Posterior pole photograph · without pupil dilation · FOV: 45 degrees.
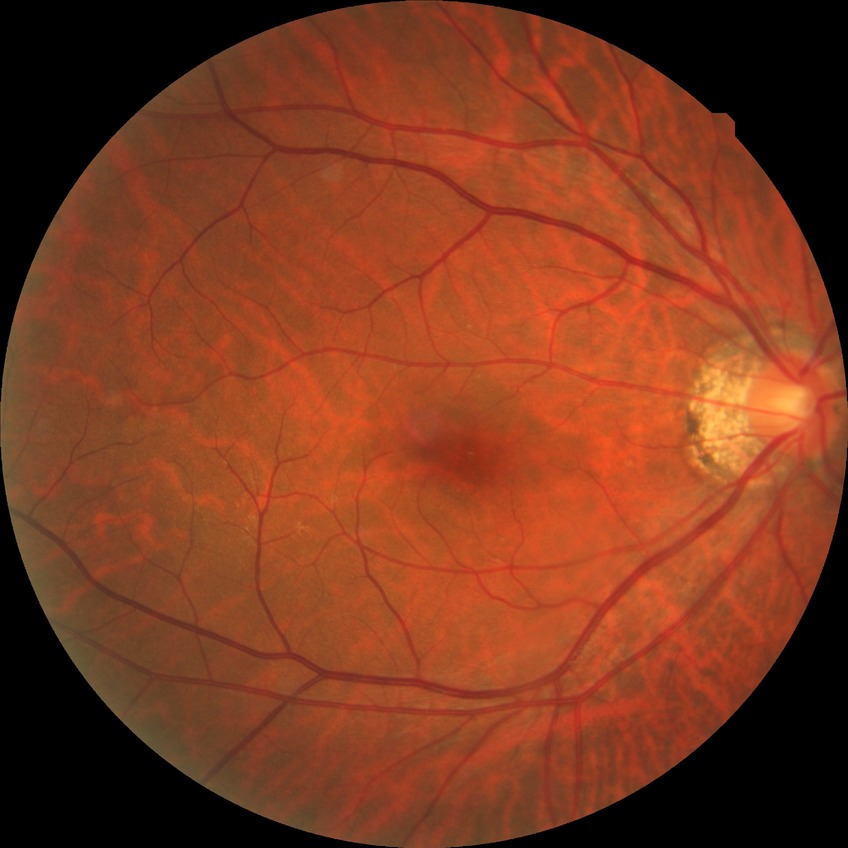
Diabetic retinopathy (DR): NDR (no diabetic retinopathy).